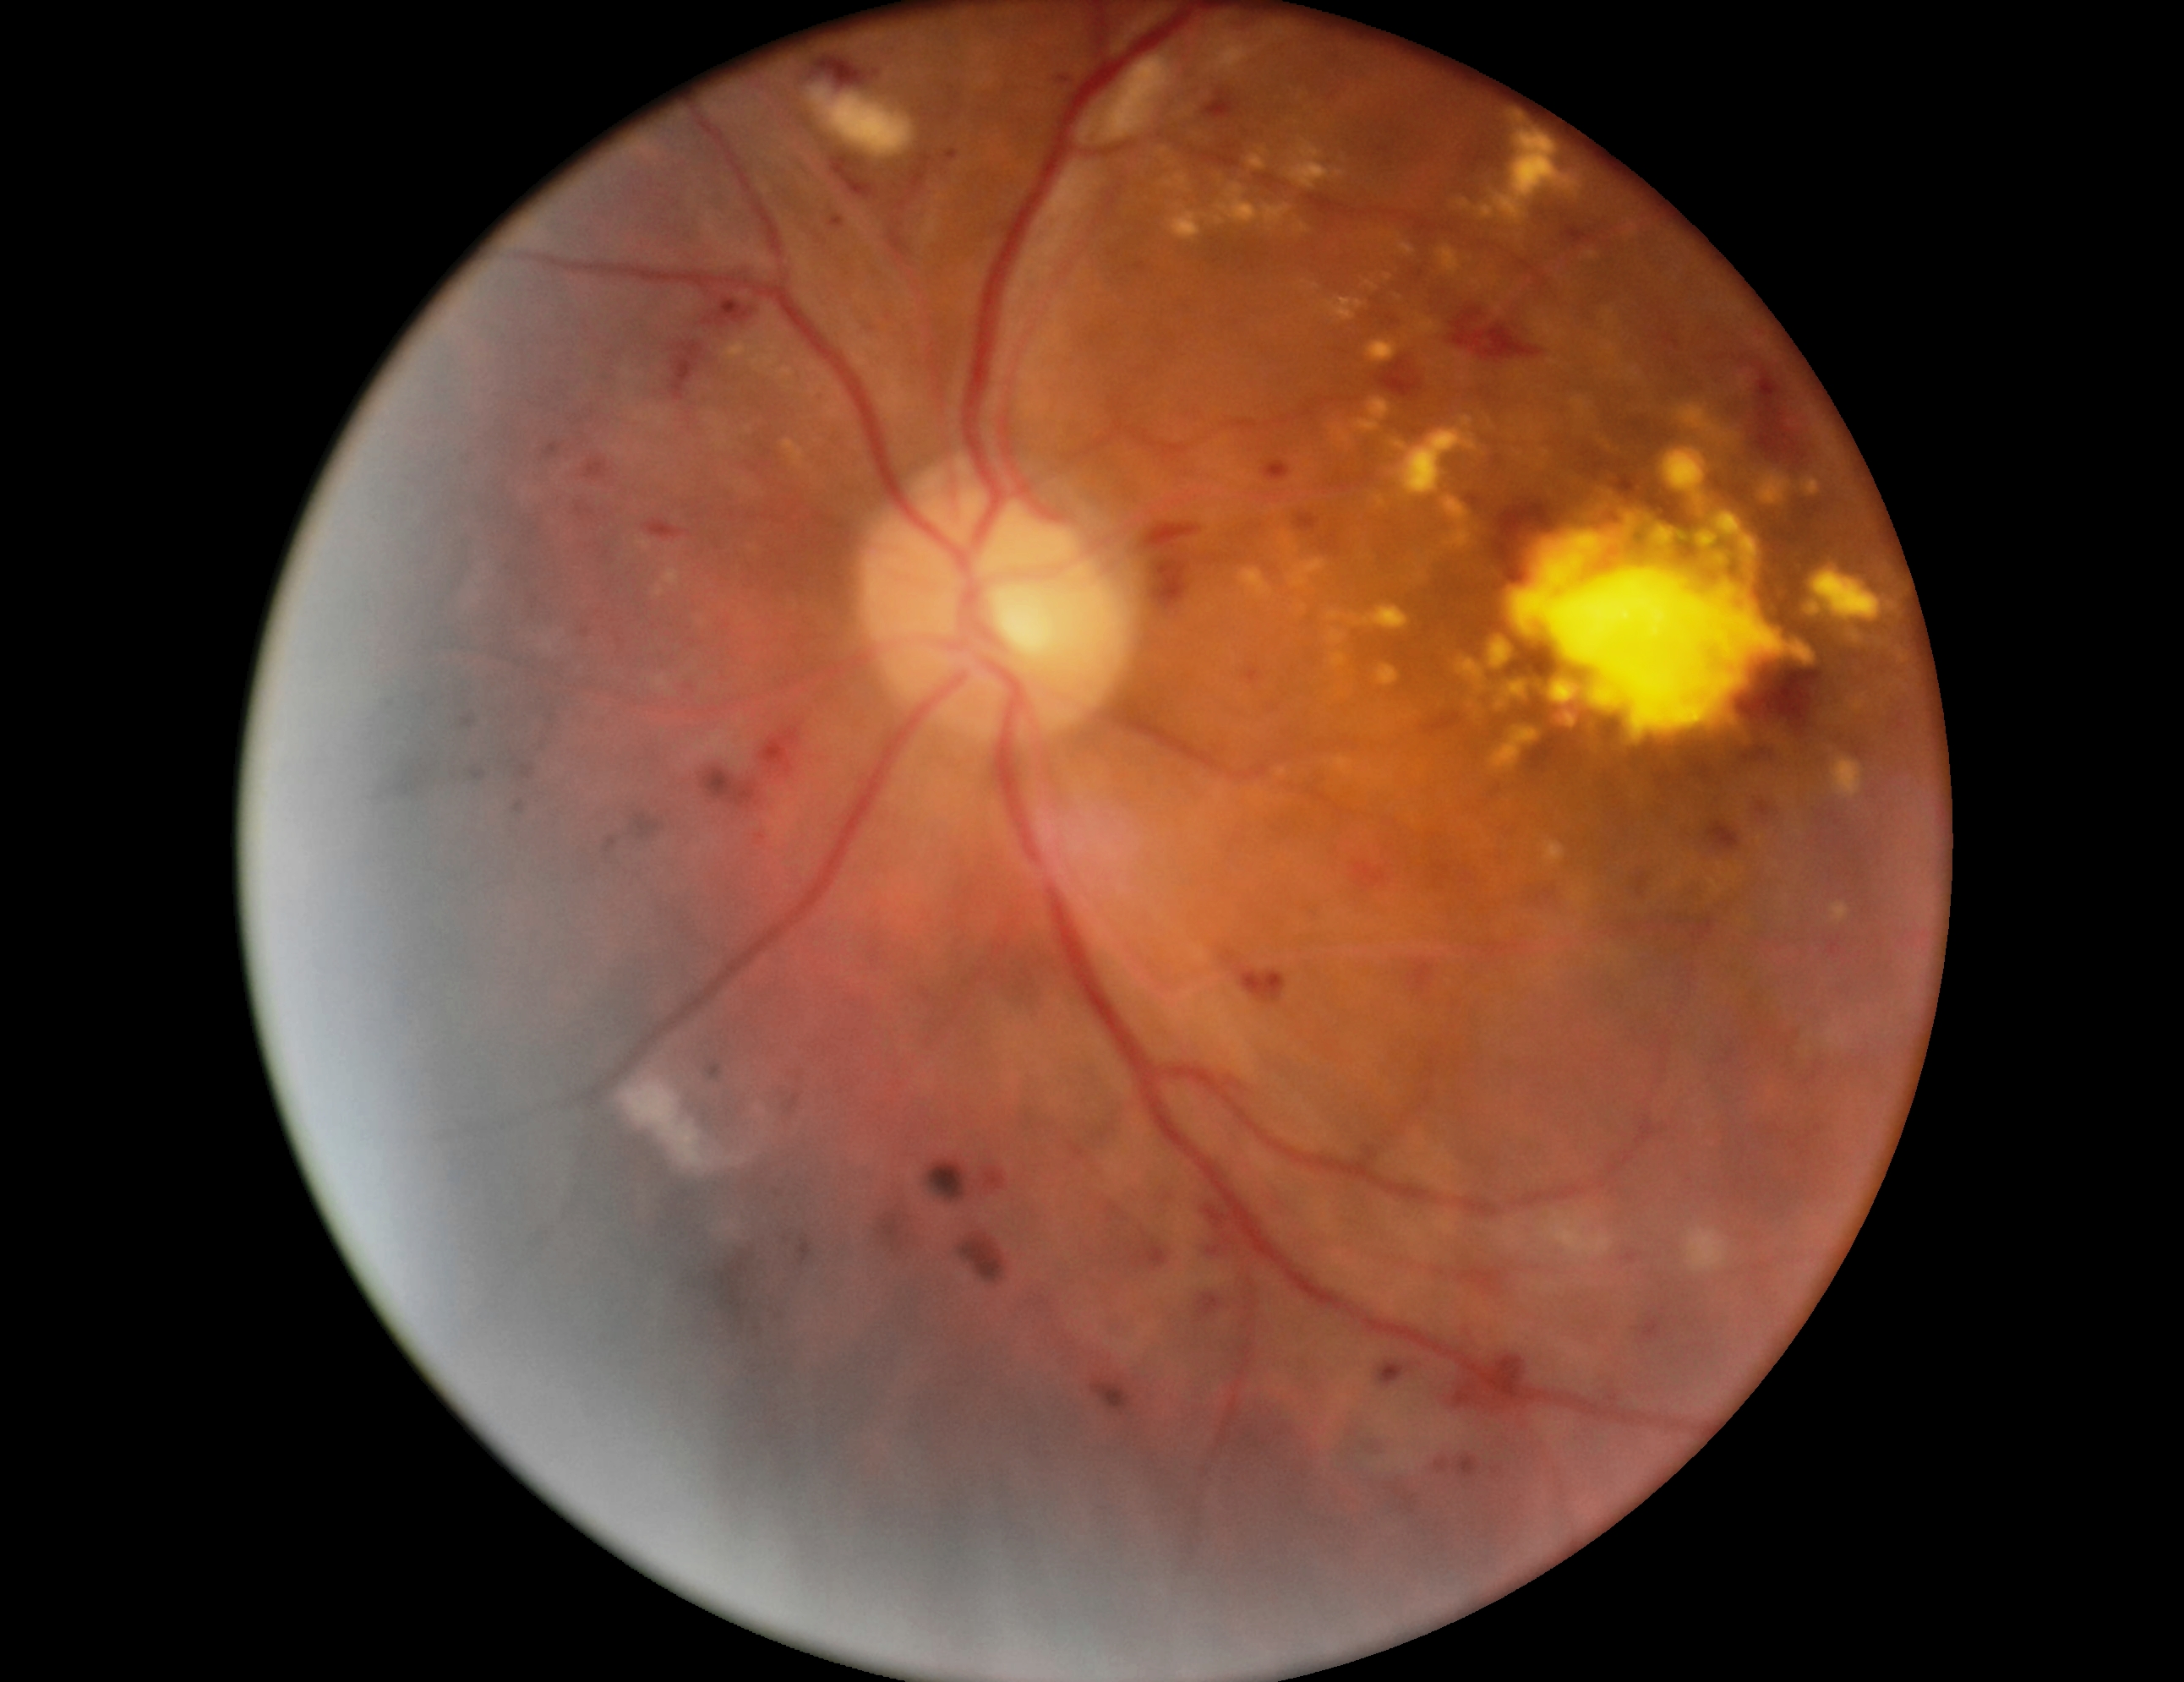

Annotations:
– retinopathy grade — 3
– DR class — non-proliferative diabetic retinopathy